Infant wide-field fundus photograph: 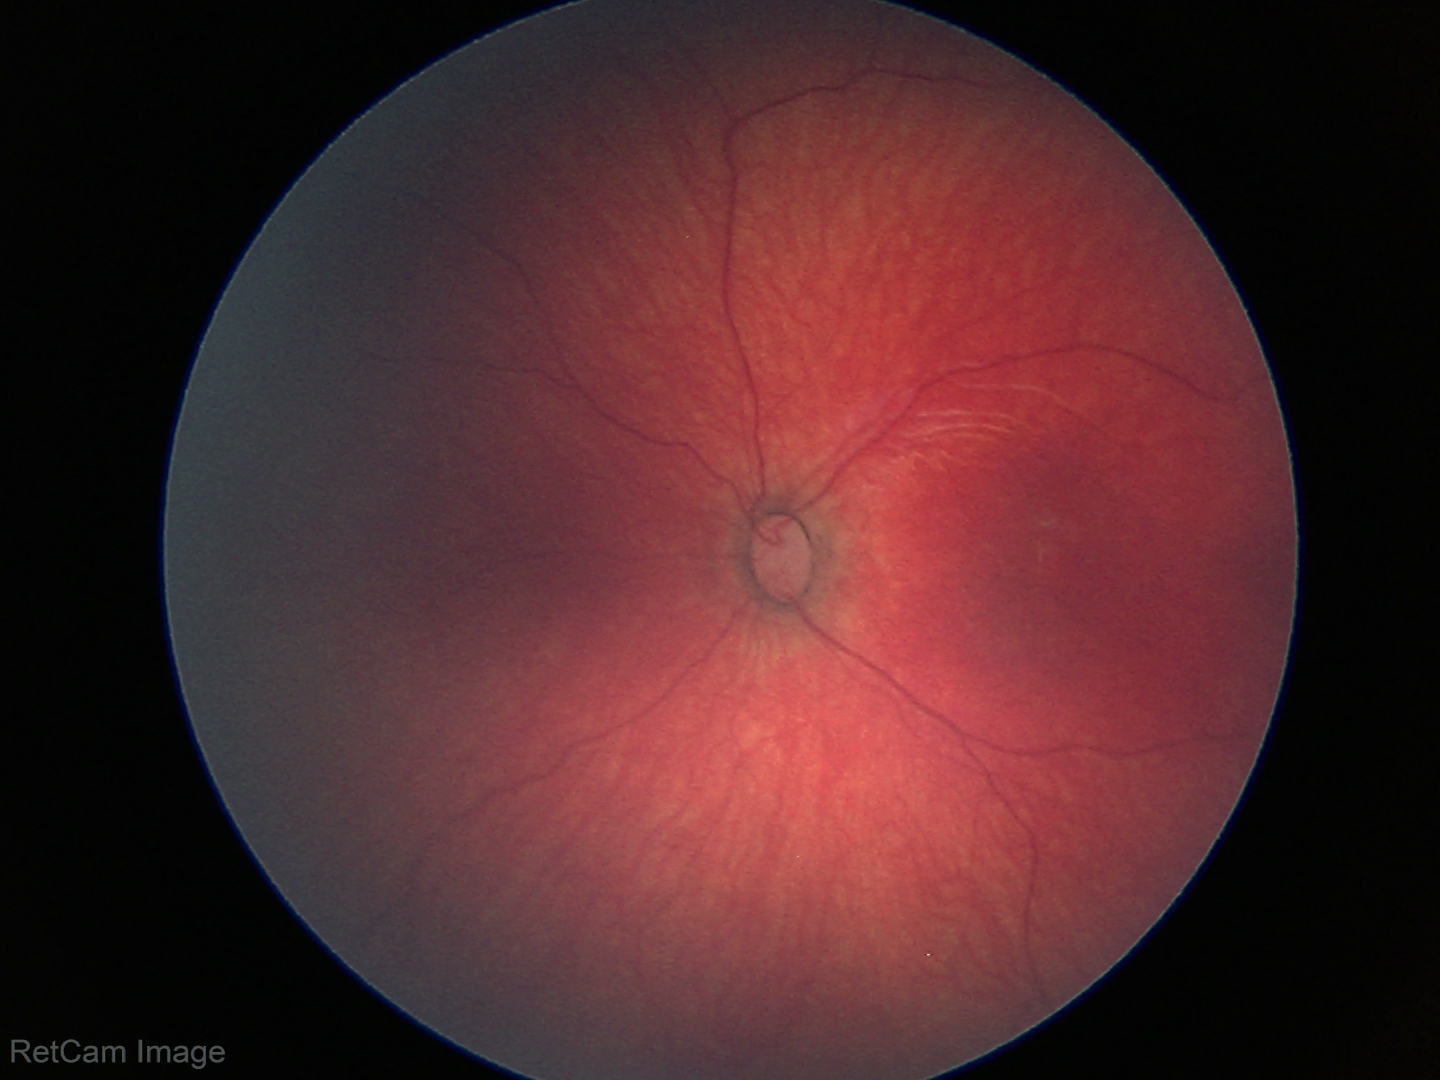 Normal screening examination.